FOV: 45 degrees
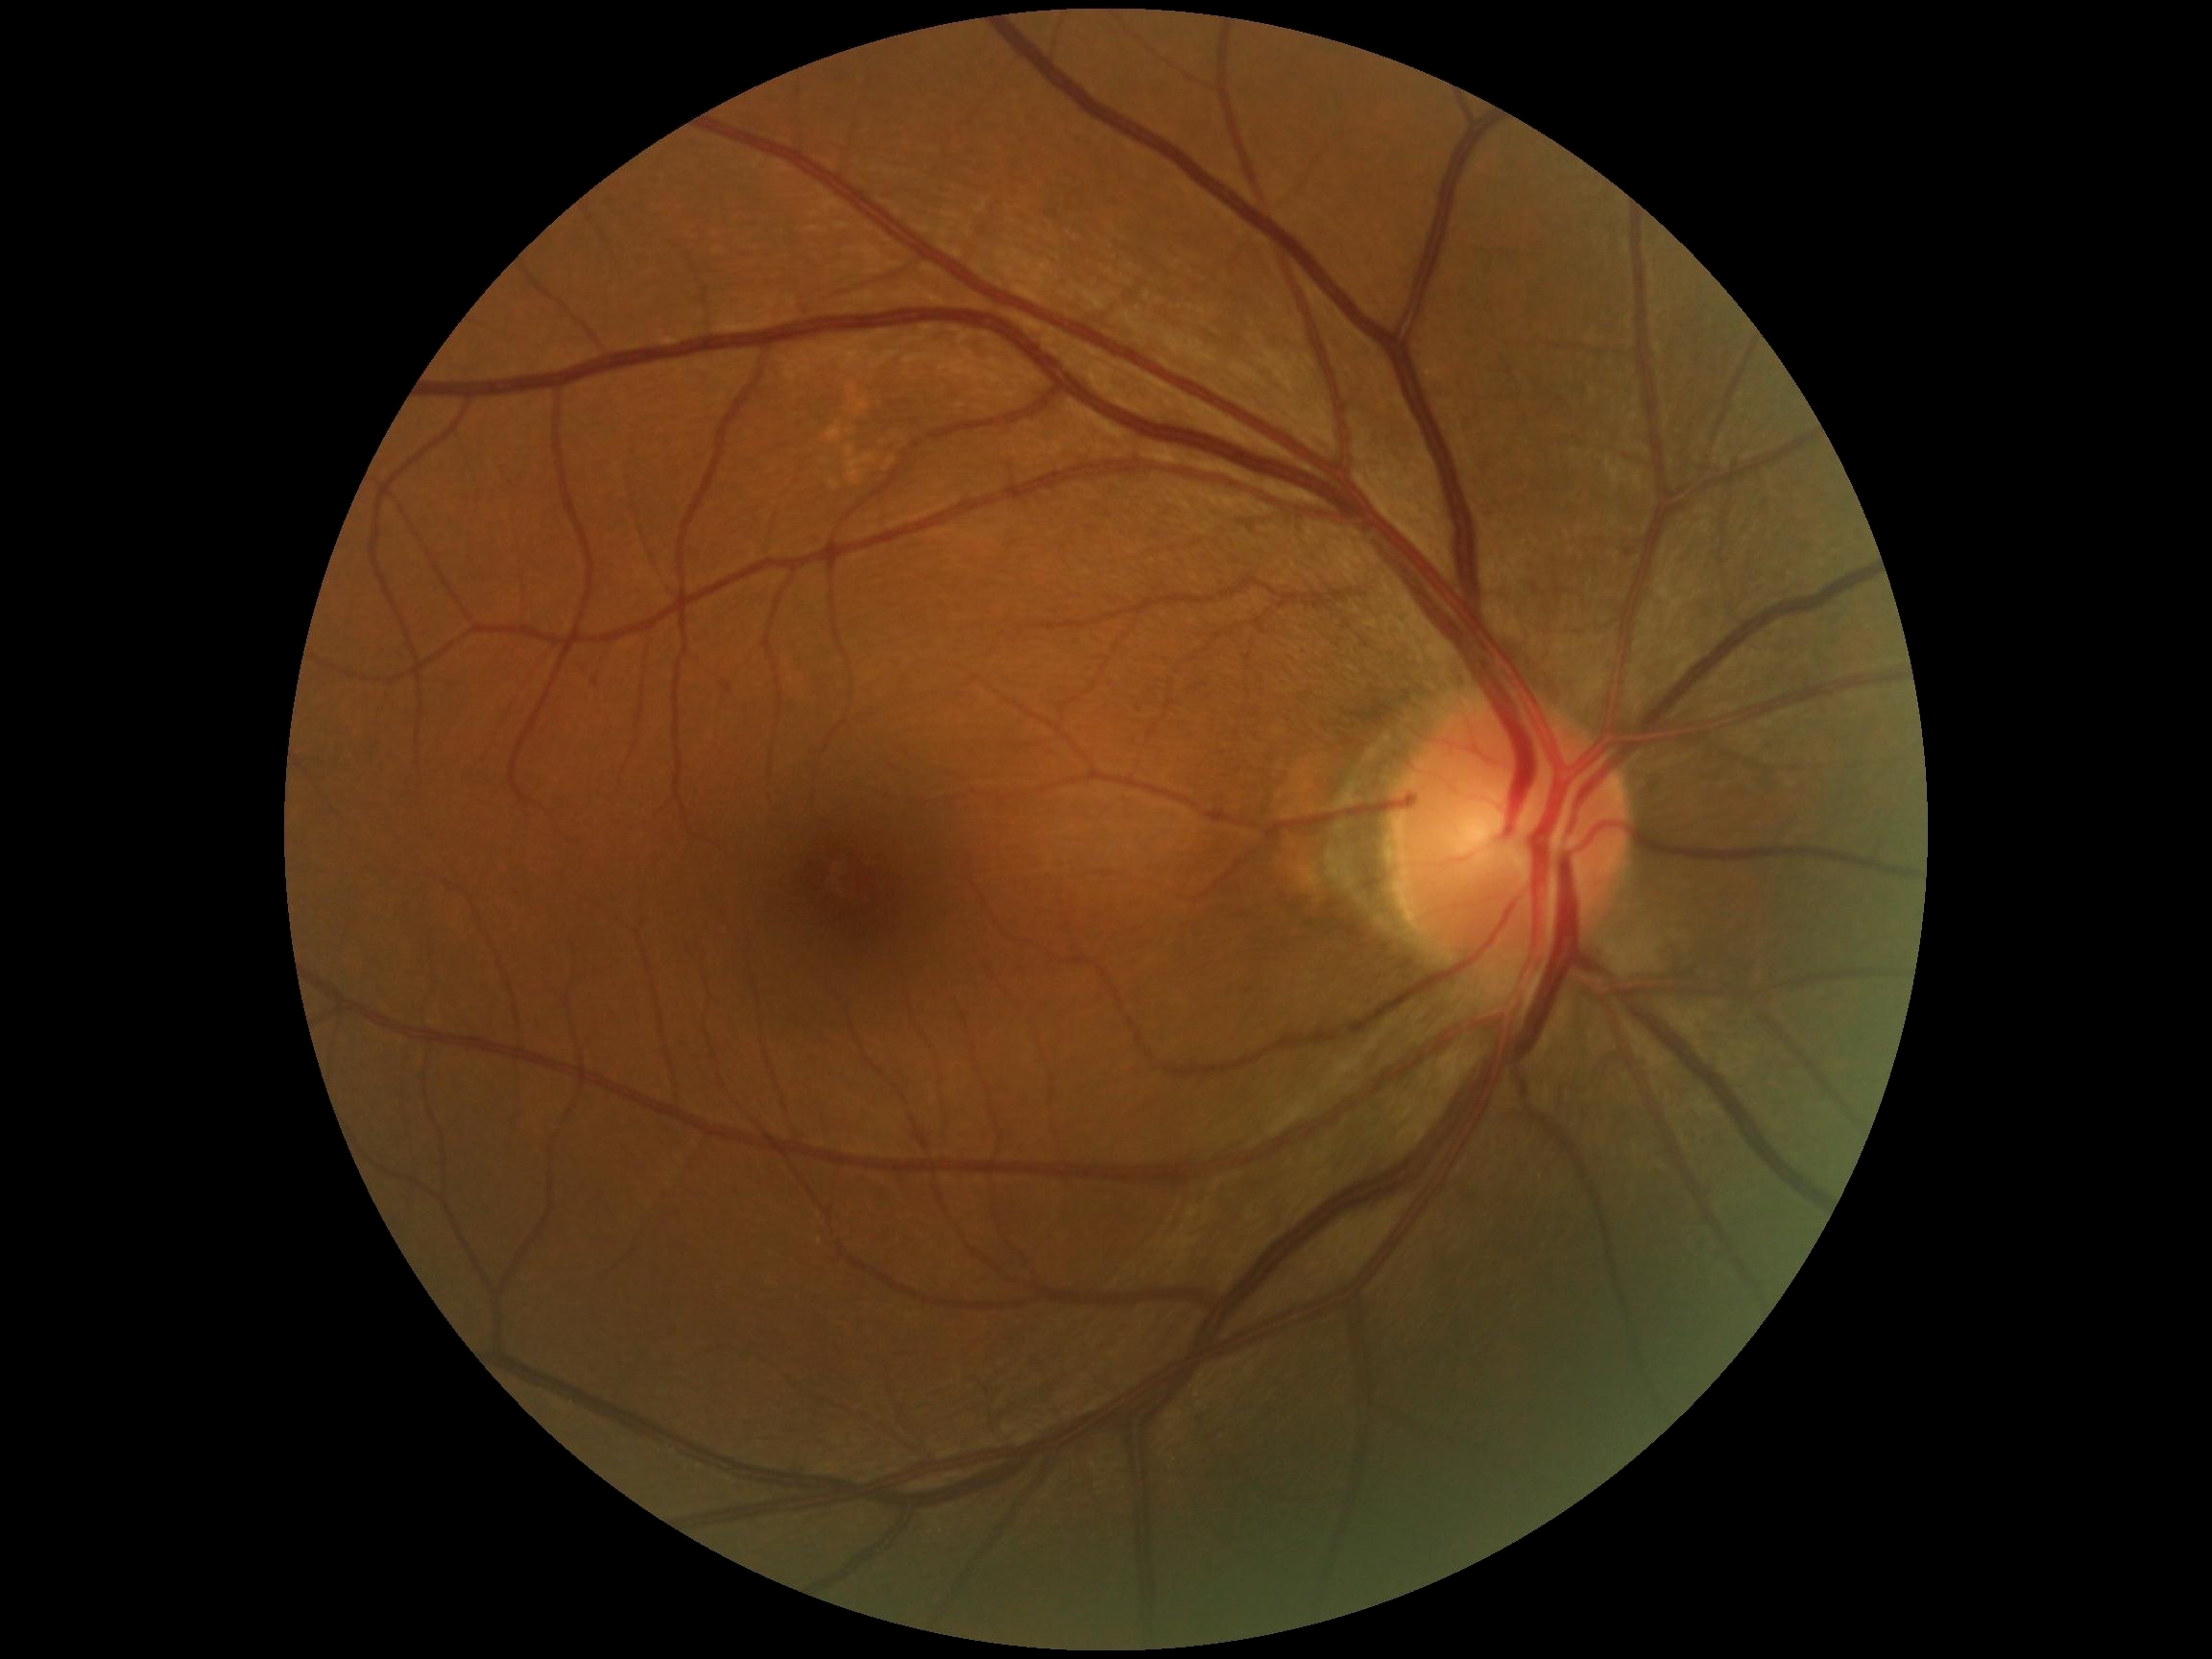
DR is grade 0.